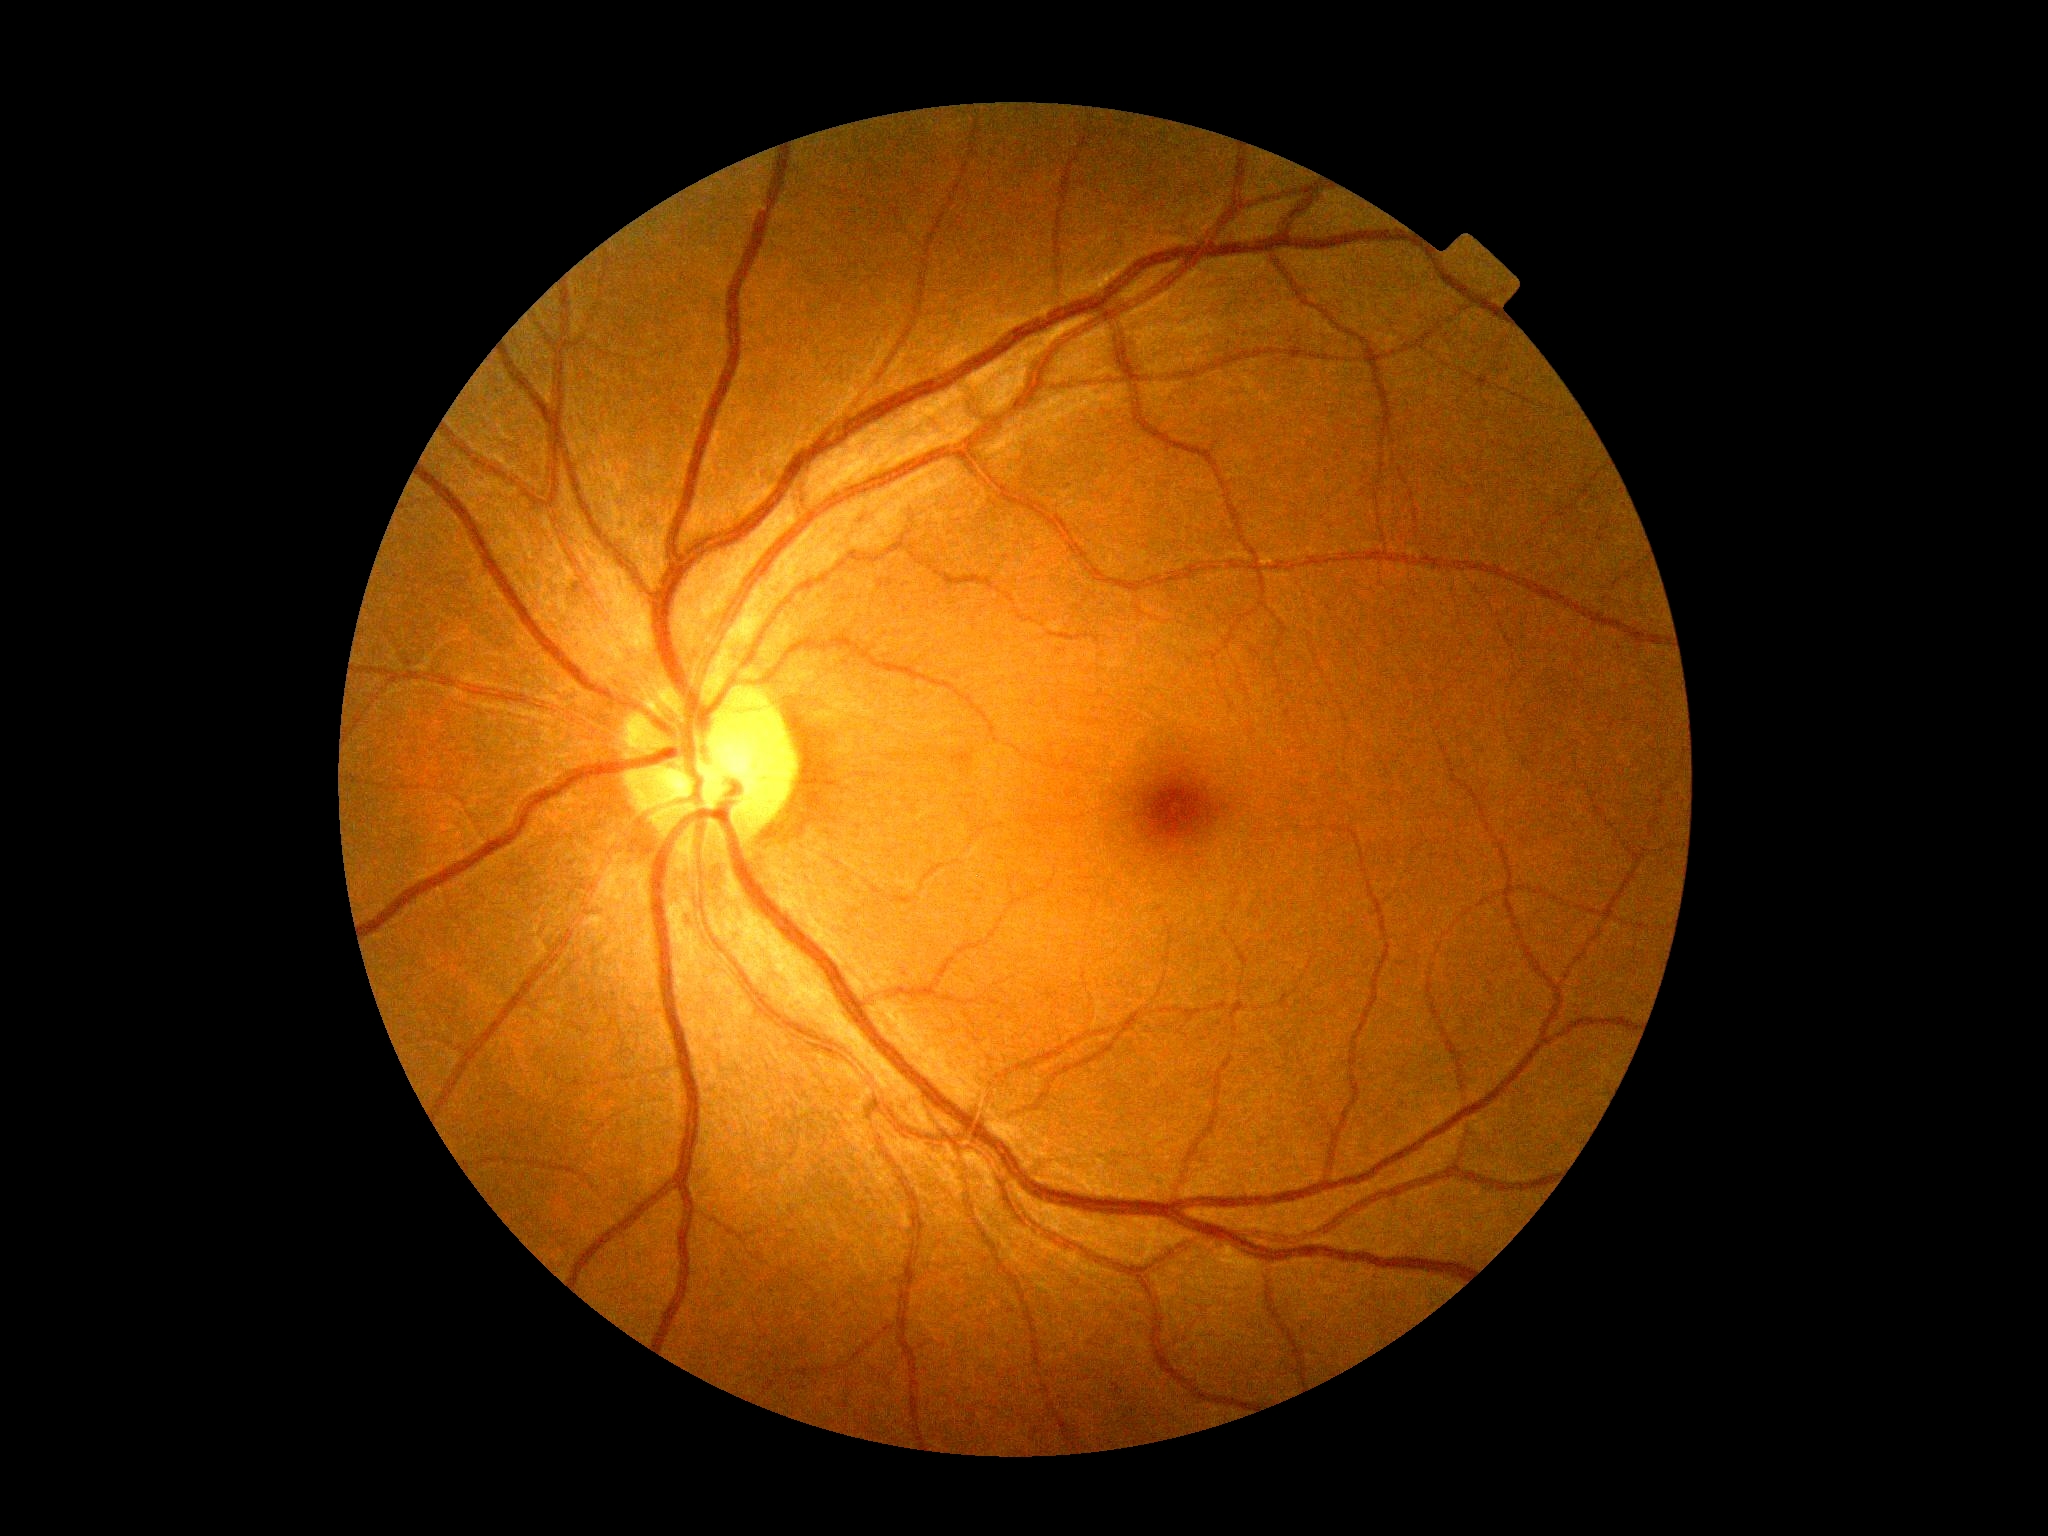
diabetic retinopathy: 0